848 by 848 pixels — 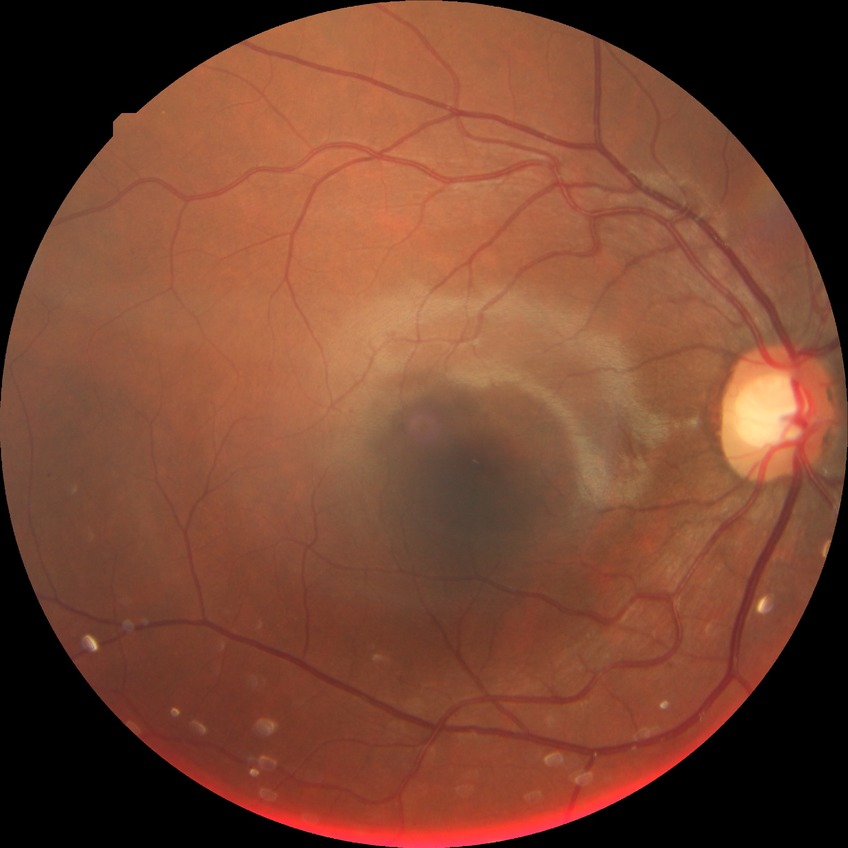 Assessment:
• diabetic retinopathy (DR): simple diabetic retinopathy (SDR)